Wide-field fundus photograph from neonatal ROP screening; acquired on the Natus RetCam Envision
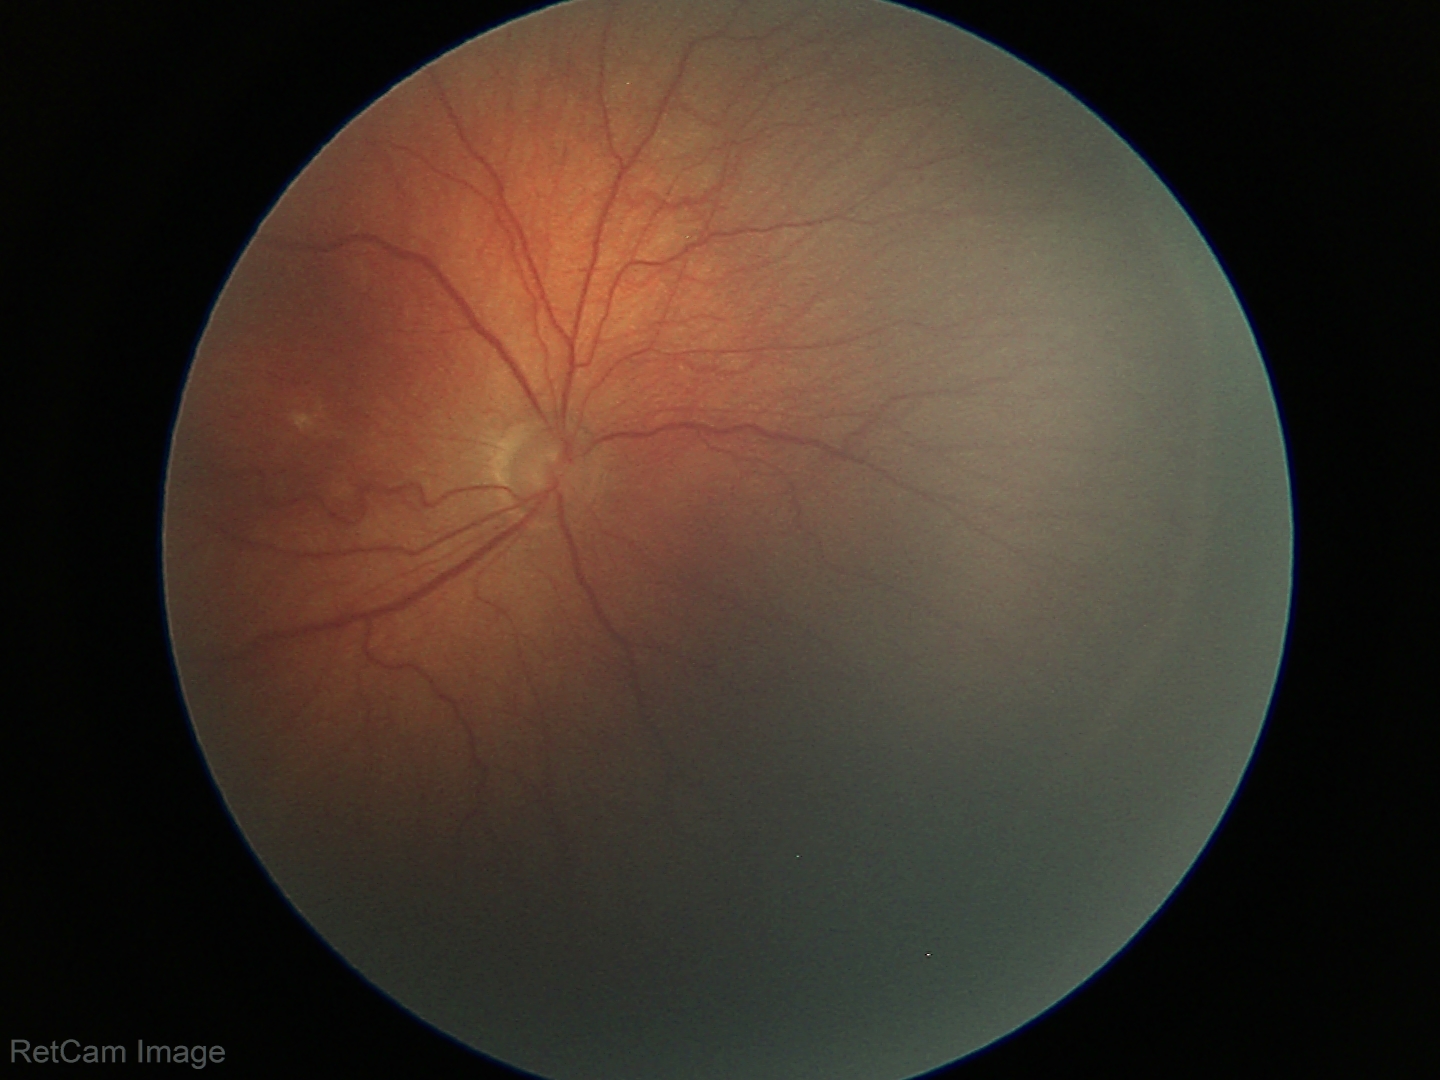 Series diagnosed as ROP stage 3 — ridge with extraretinal fibrovascular proliferation.